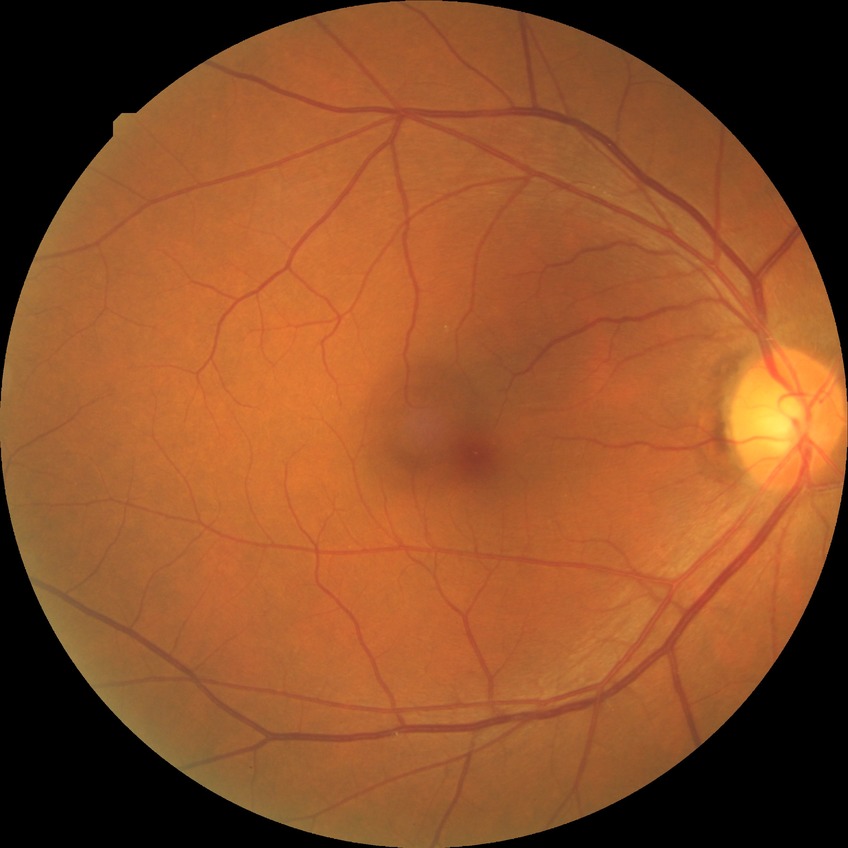
Assessment:
– DR stage — NDR
– DR impression — no DR findings